2048 by 1536 pixels, color fundus image: 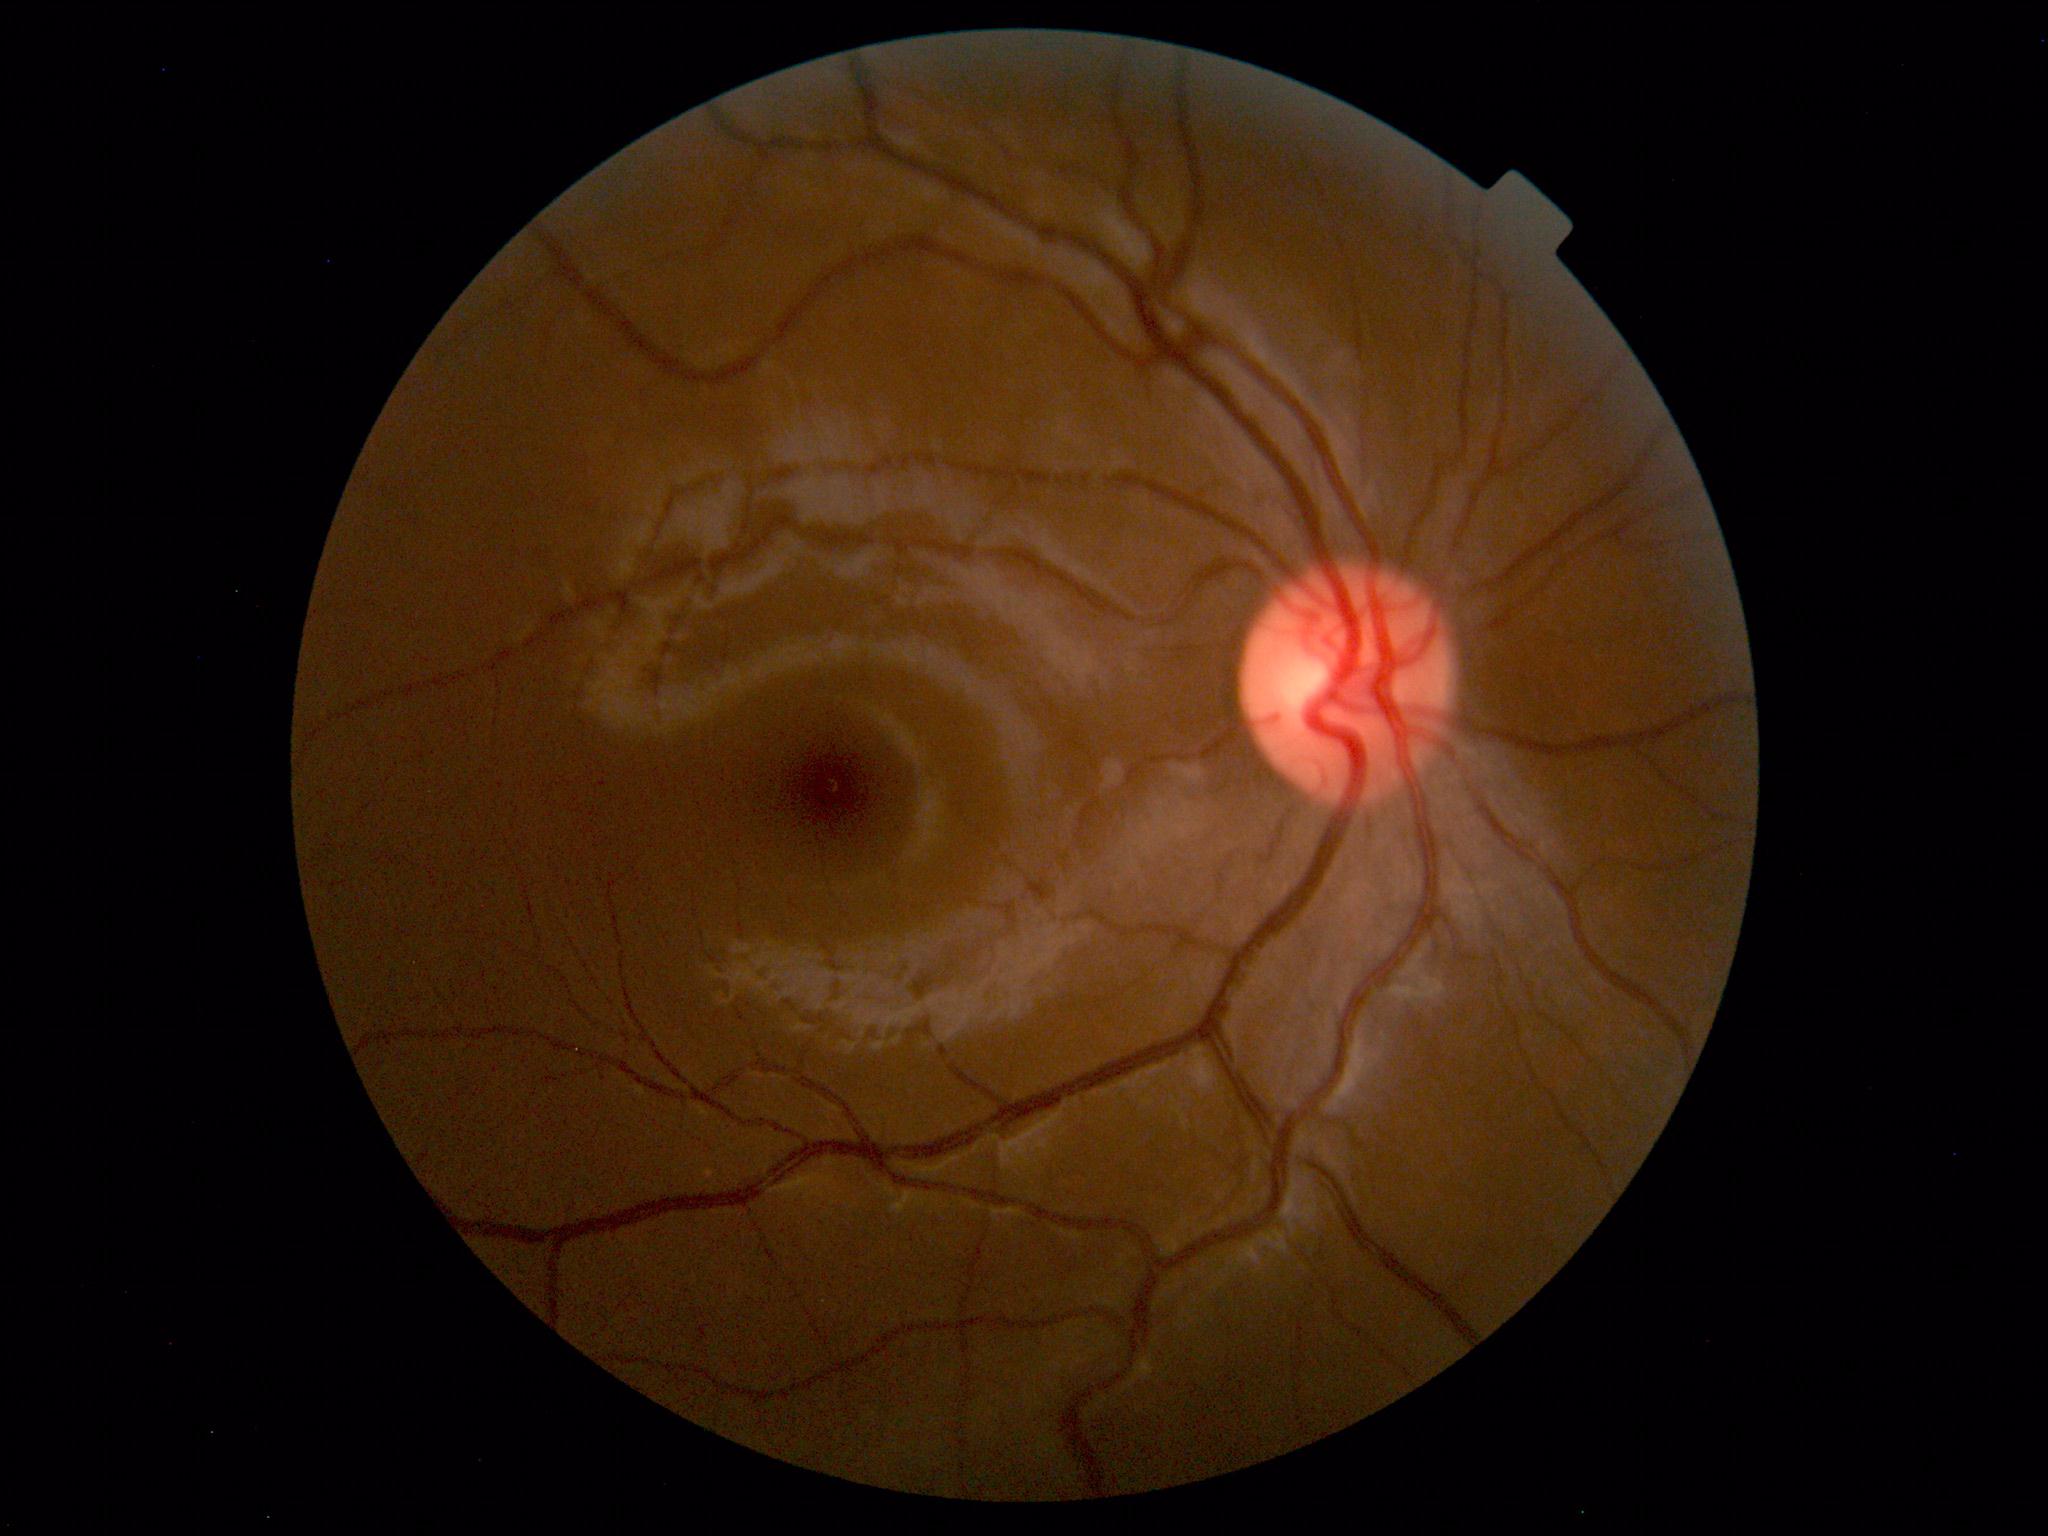

Diagnosis: normal.